Color fundus photograph:
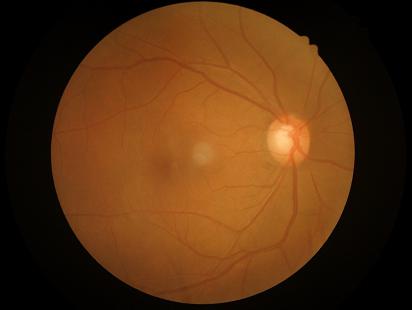
Quality grading:
- contrast: adequate
- sharpness: clear
- overall: satisfactory
- illumination: adequate